Image size 848x848
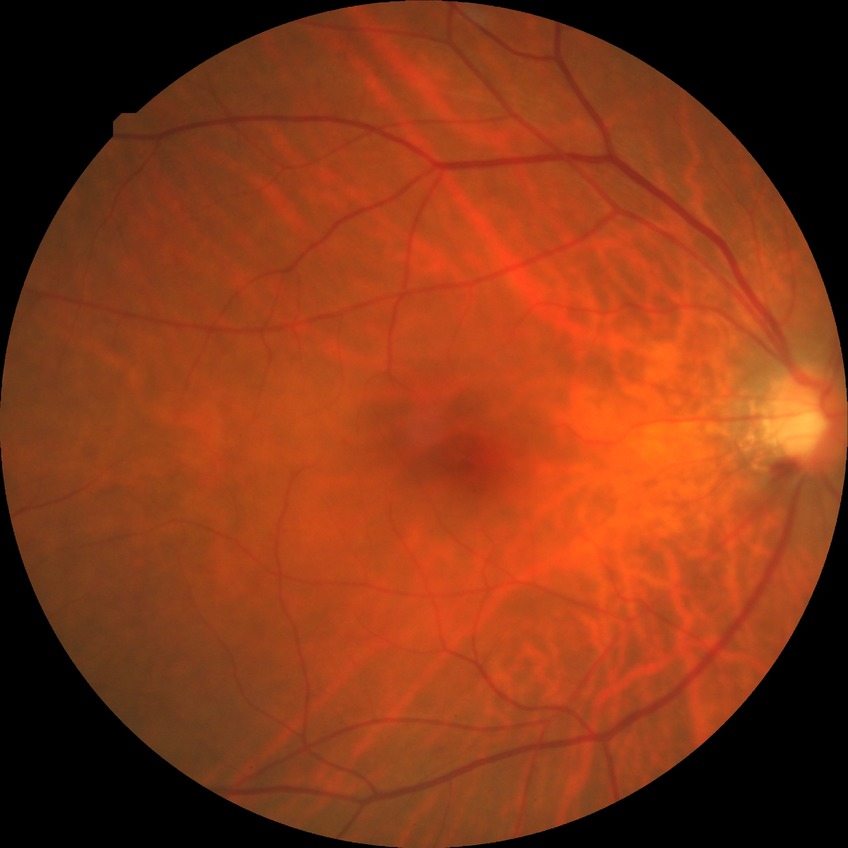

Diabetic retinopathy (DR): NDR (no diabetic retinopathy).